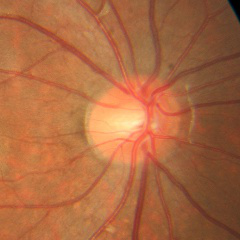

Findings consistent with no glaucomatous changes.